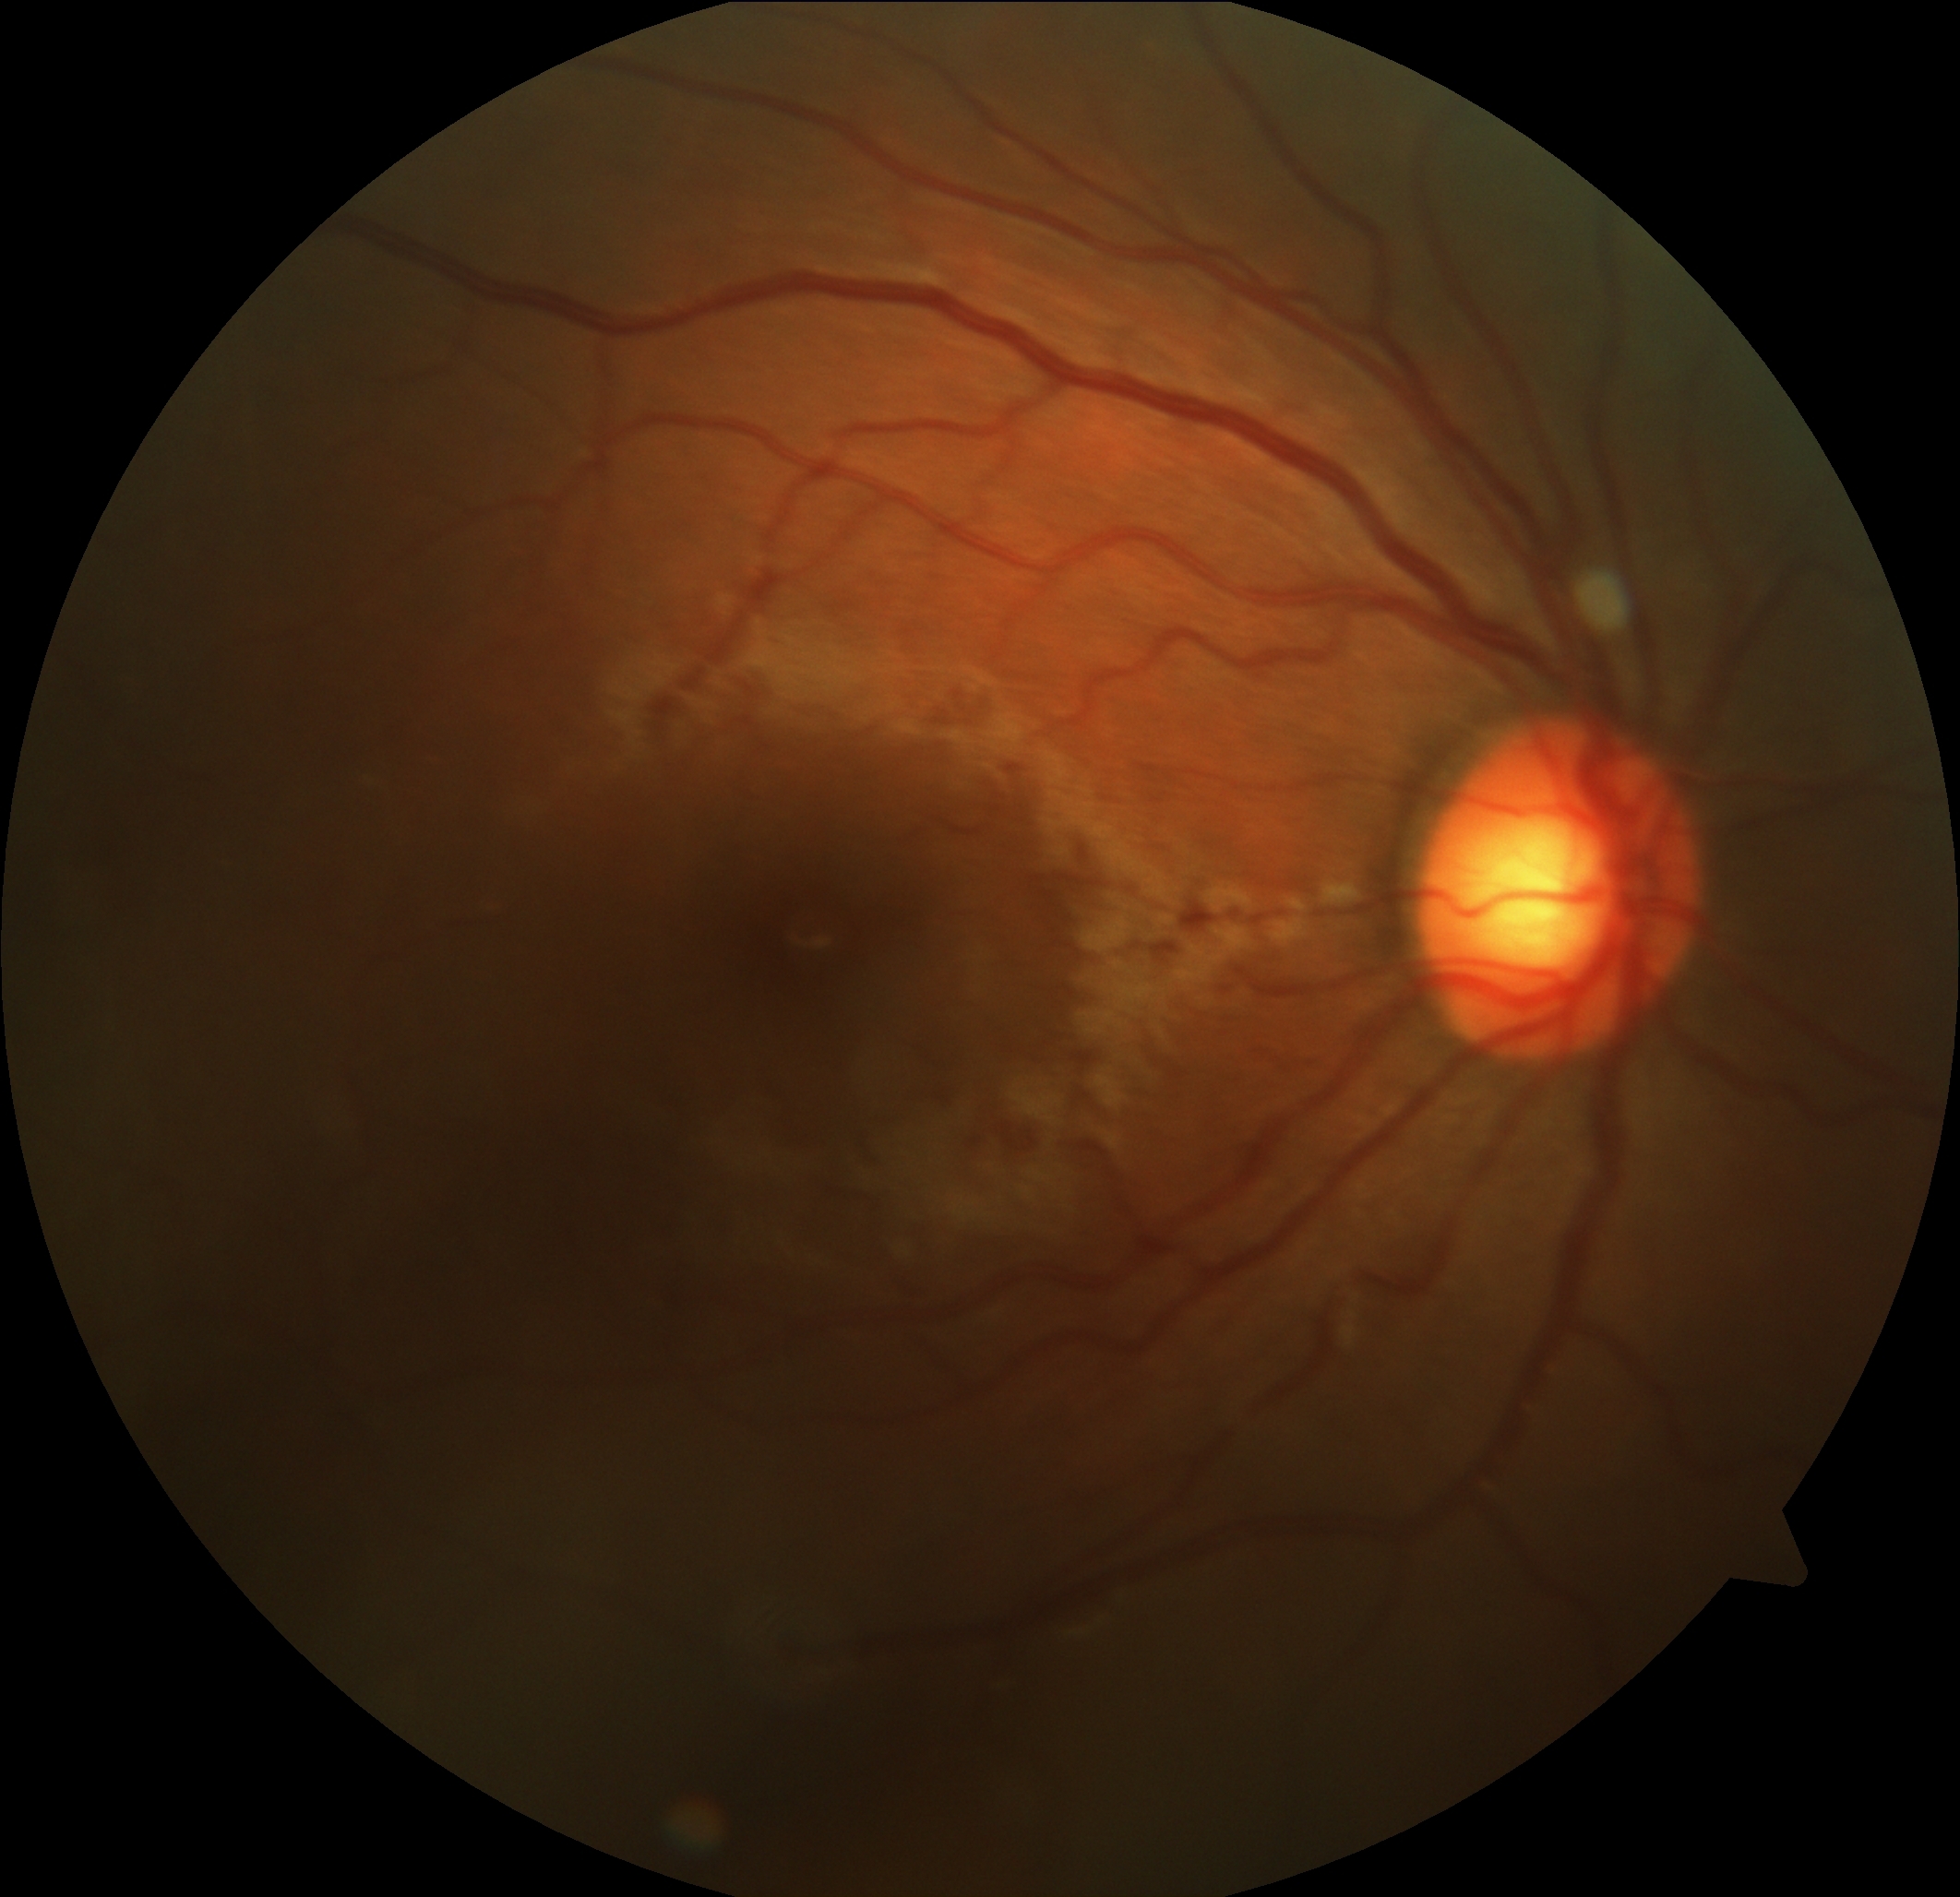

  dr_grade: 0
  dr_impression: no apparent DR